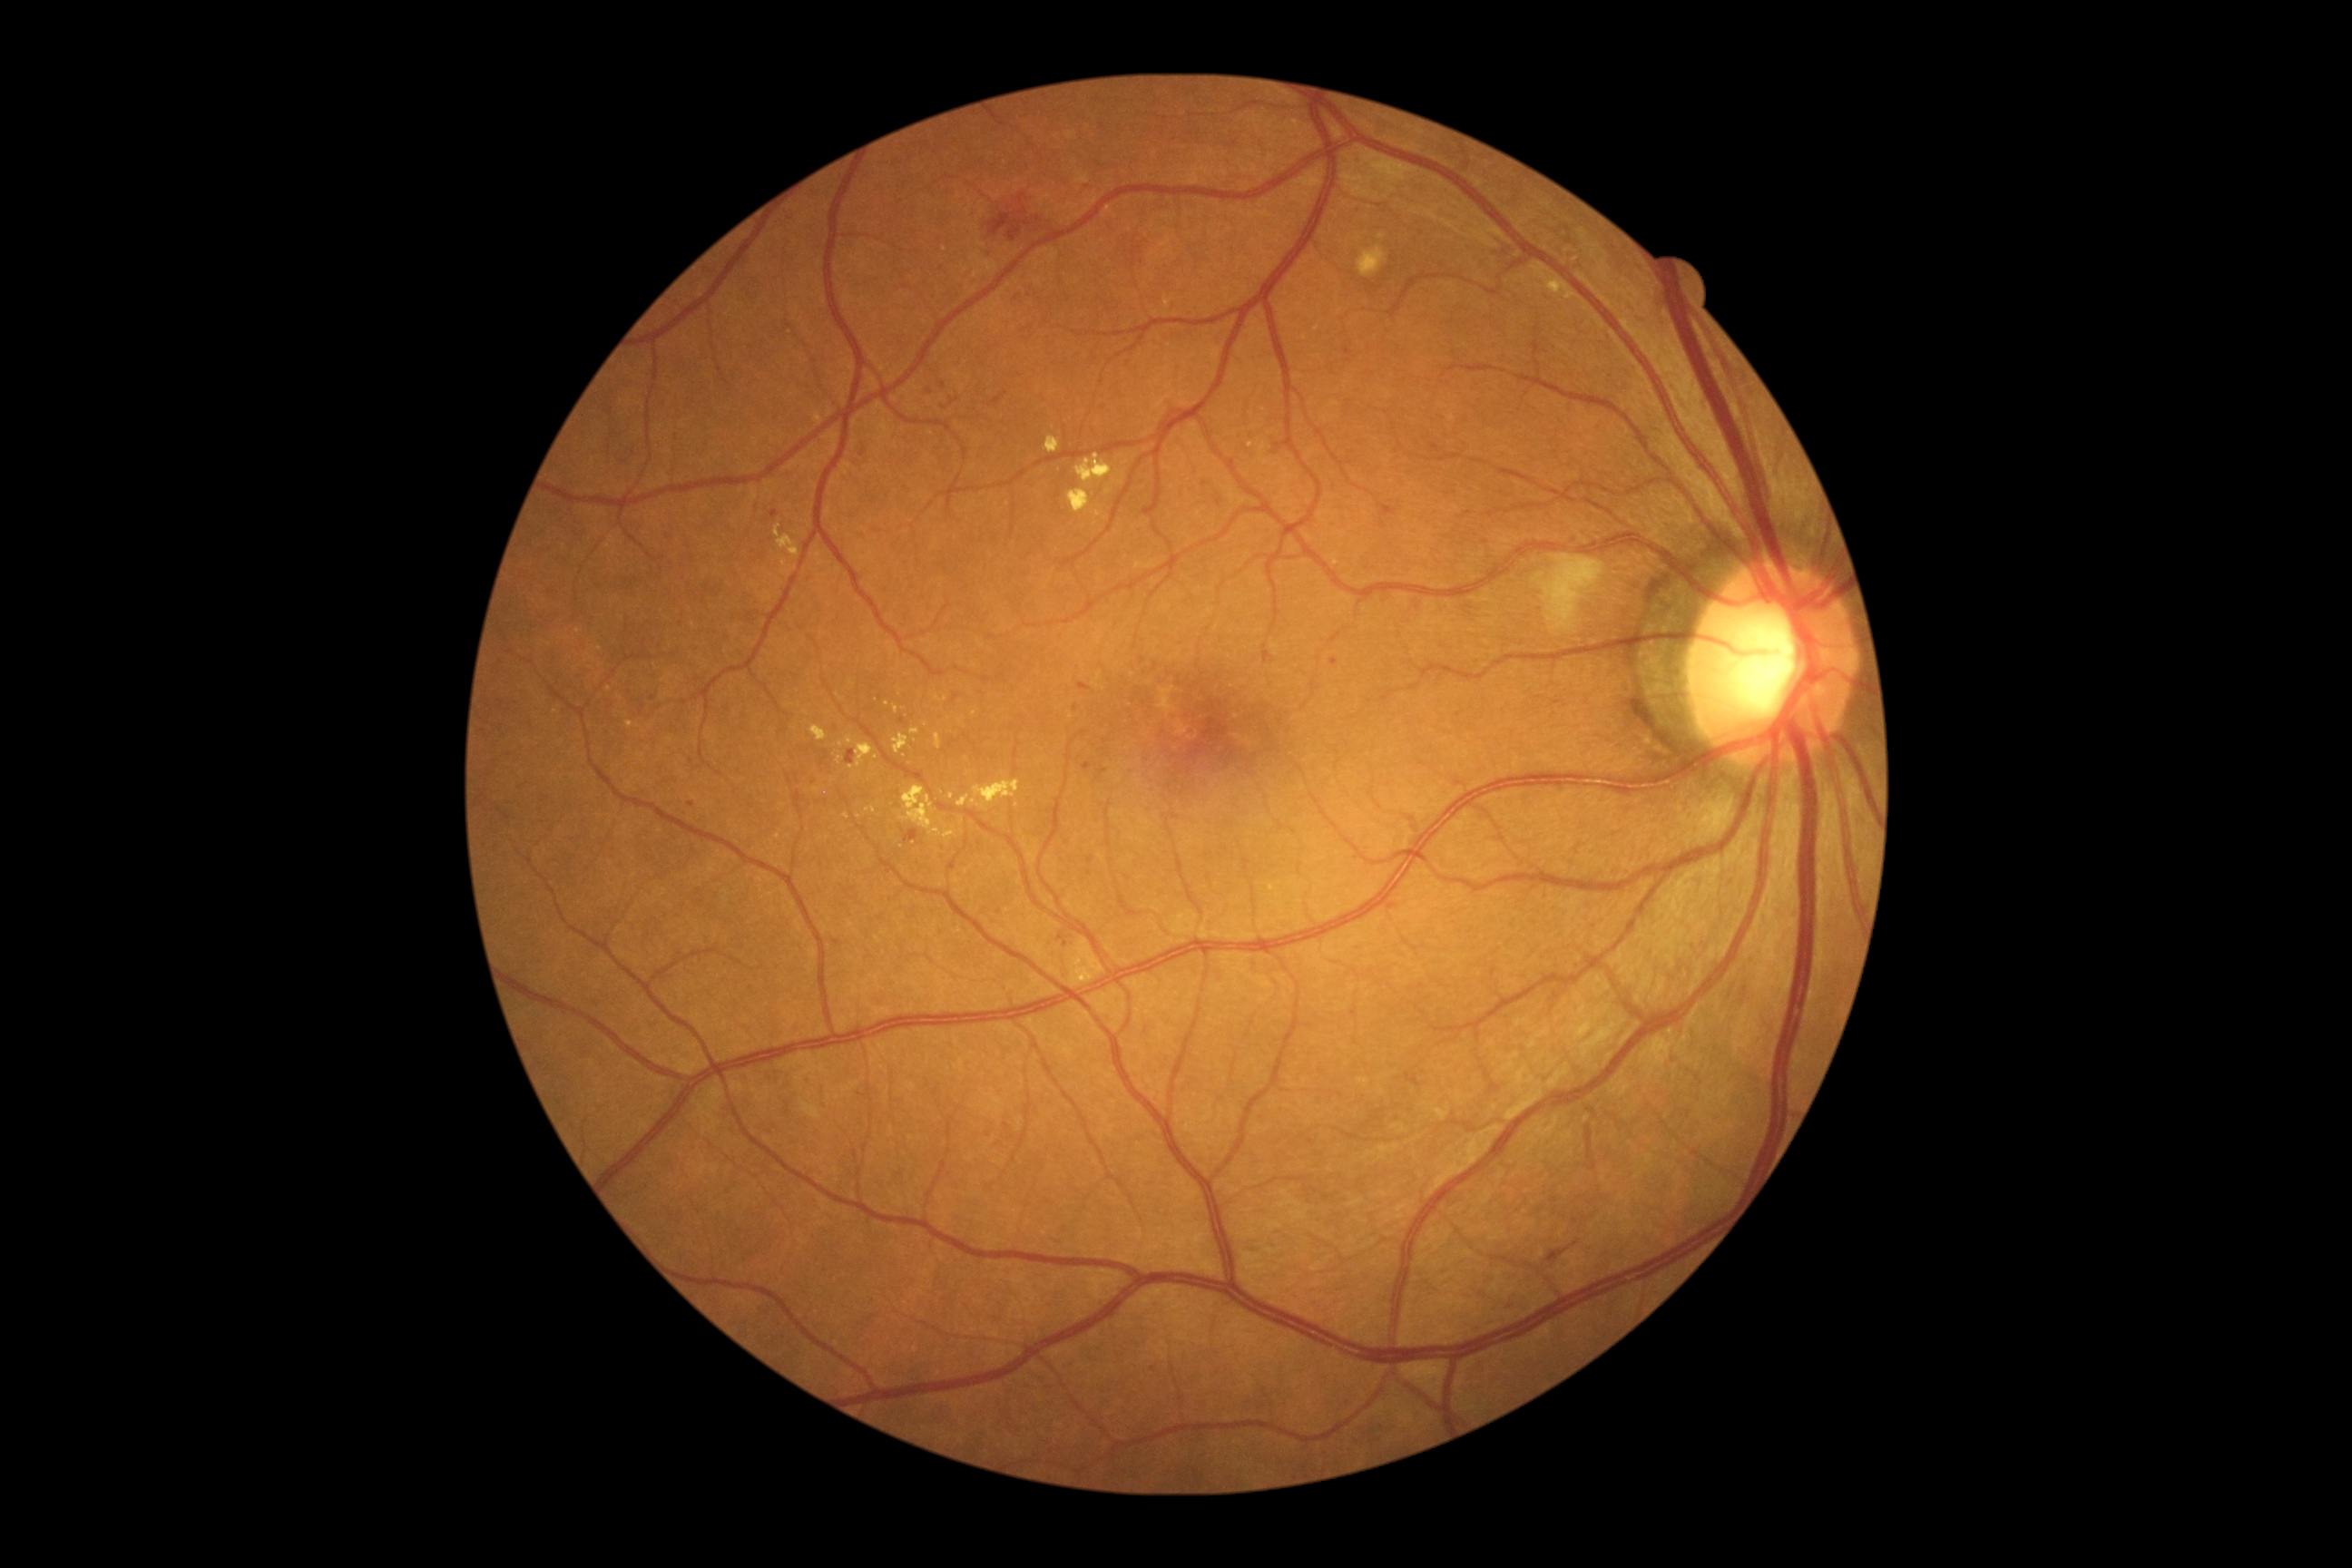

diabetic retinopathy (DR) = grade 2 (moderate NPDR).